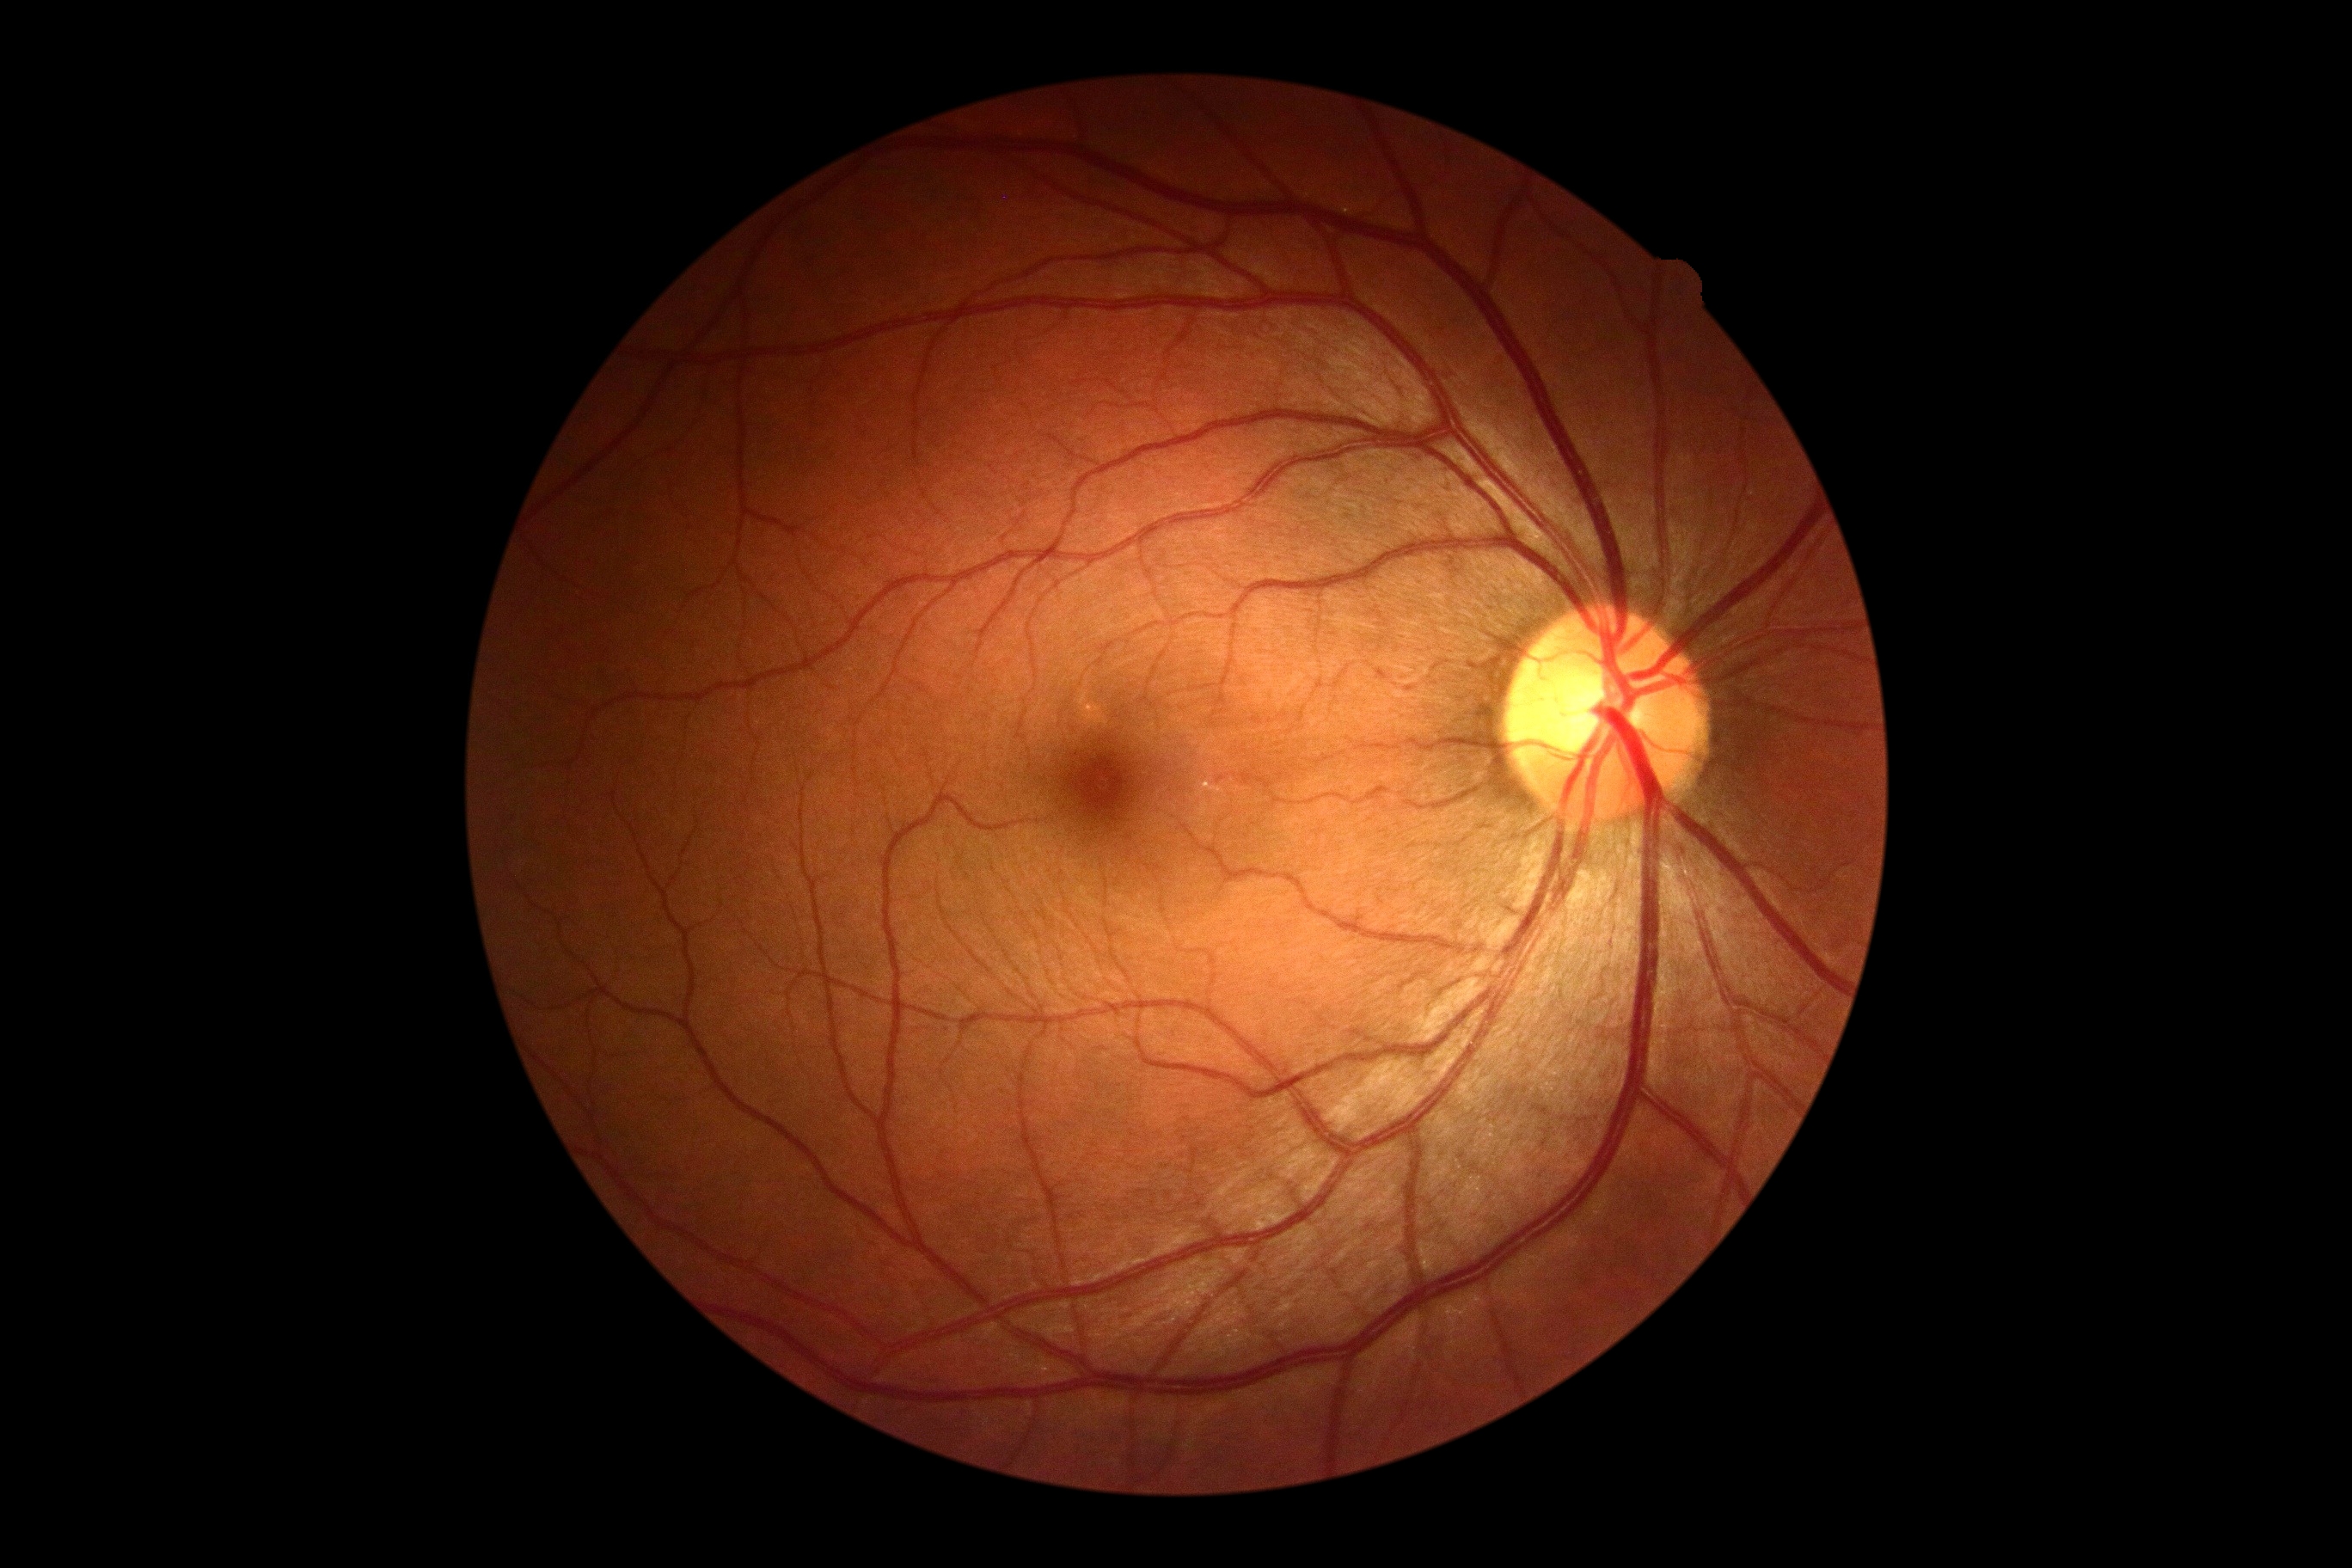
DR stage: no apparent retinopathy (grade 0).